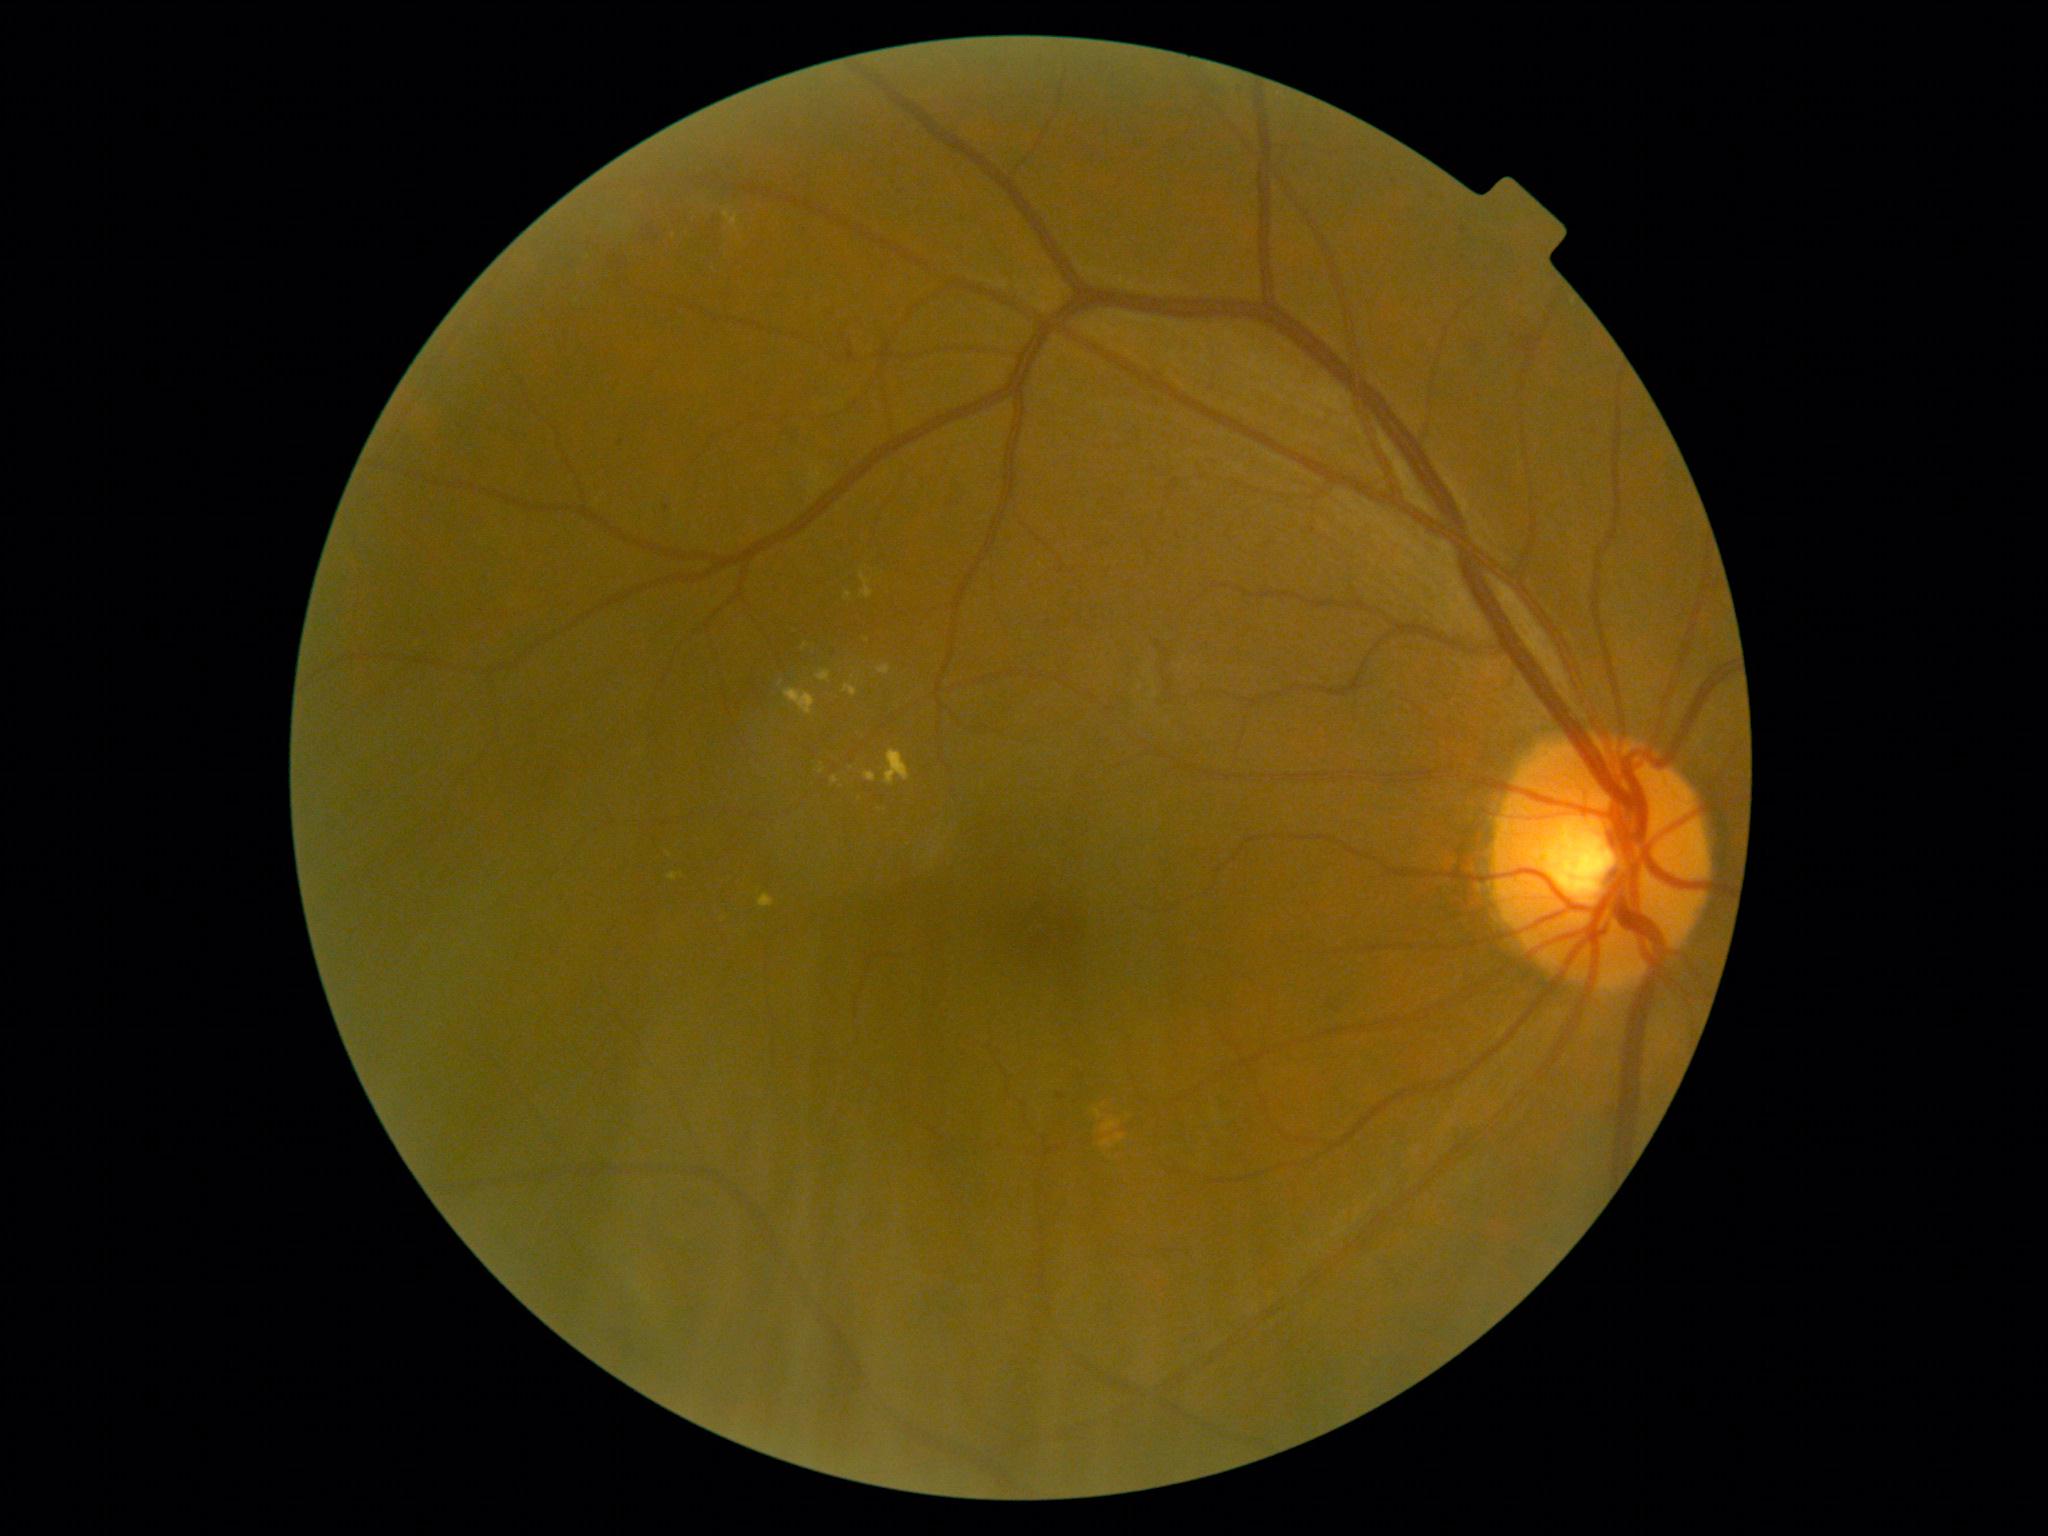
DR stage: grade 2 (moderate NPDR)
Selected lesions:
HEs: rect(638, 221, 654, 247), rect(698, 218, 721, 257), rect(664, 505, 670, 513), rect(1057, 1093, 1066, 1100), rect(614, 257, 637, 280)
Smaller HEs around pt(1394, 183), pt(621, 444), pt(1463, 230)
MAs: none identified
EXs (continued): rect(877, 666, 891, 676), rect(831, 776, 840, 784), rect(817, 670, 831, 684), rect(844, 591, 853, 600), rect(886, 750, 911, 786), rect(724, 211, 740, 231), rect(784, 688, 815, 716), rect(844, 684, 858, 697), rect(860, 571, 874, 600), rect(668, 873, 678, 881), rect(864, 773, 877, 783), rect(758, 894, 775, 907)
Smaller EXs around pt(782, 683), pt(682, 875), pt(670, 855), pt(868, 640), pt(821, 771), pt(805, 647)
SEs: none identified